130° field of view (Clarity RetCam 3). Infant wide-field fundus photograph. 640 x 480 pixels
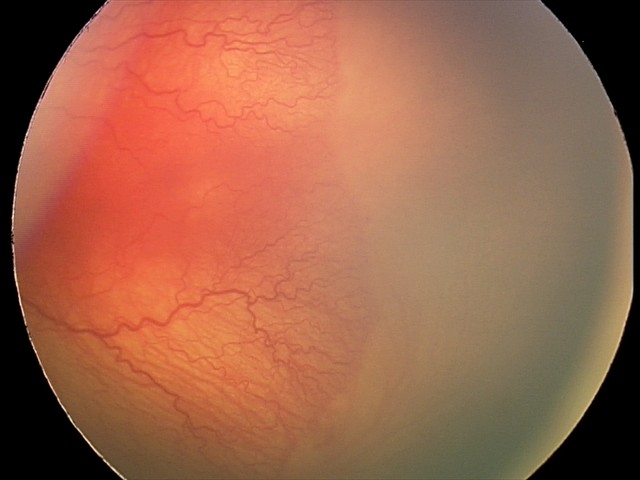 Screening examination consistent with A-ROP (aggressive ROP). Plus disease present.